Color fundus photograph — 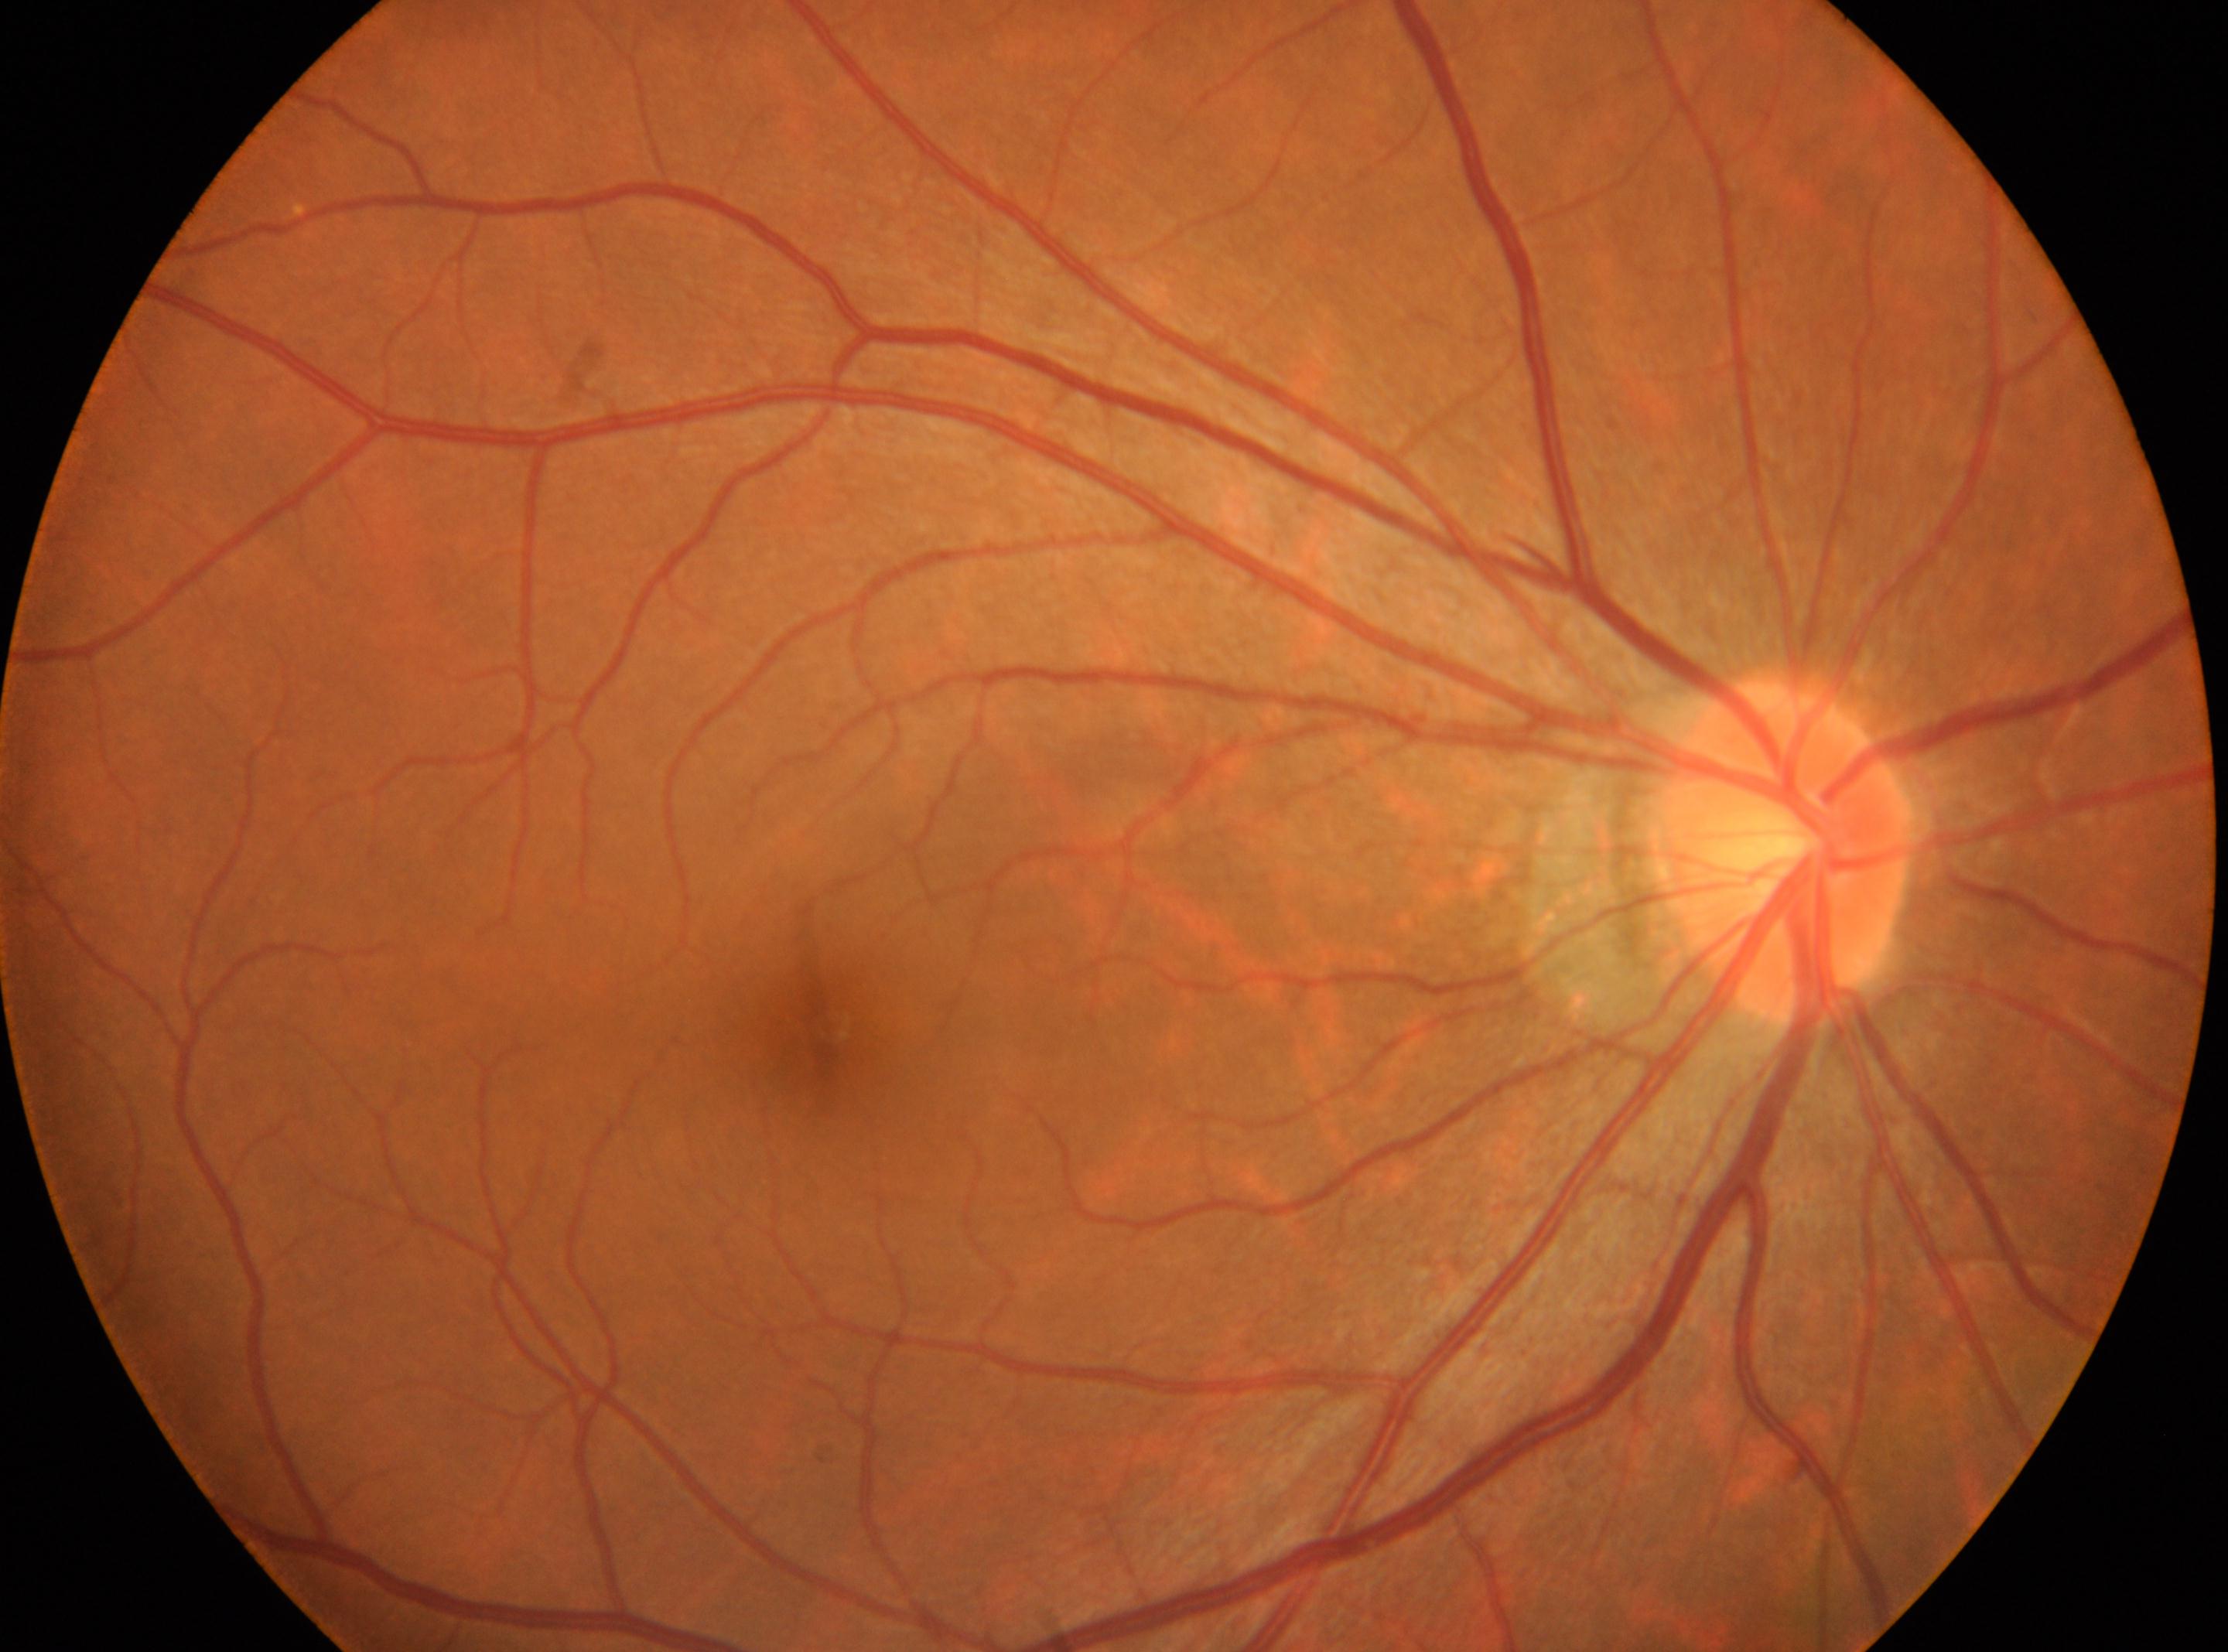

DR stage: no apparent diabetic retinopathy (grade 0); laterality: right eye; optic disk: [1782, 852]; macula center: [832, 1026].